Captured with the Phoenix ICON (100° field of view). Image size 1240x1240. Wide-field fundus photograph of an infant.
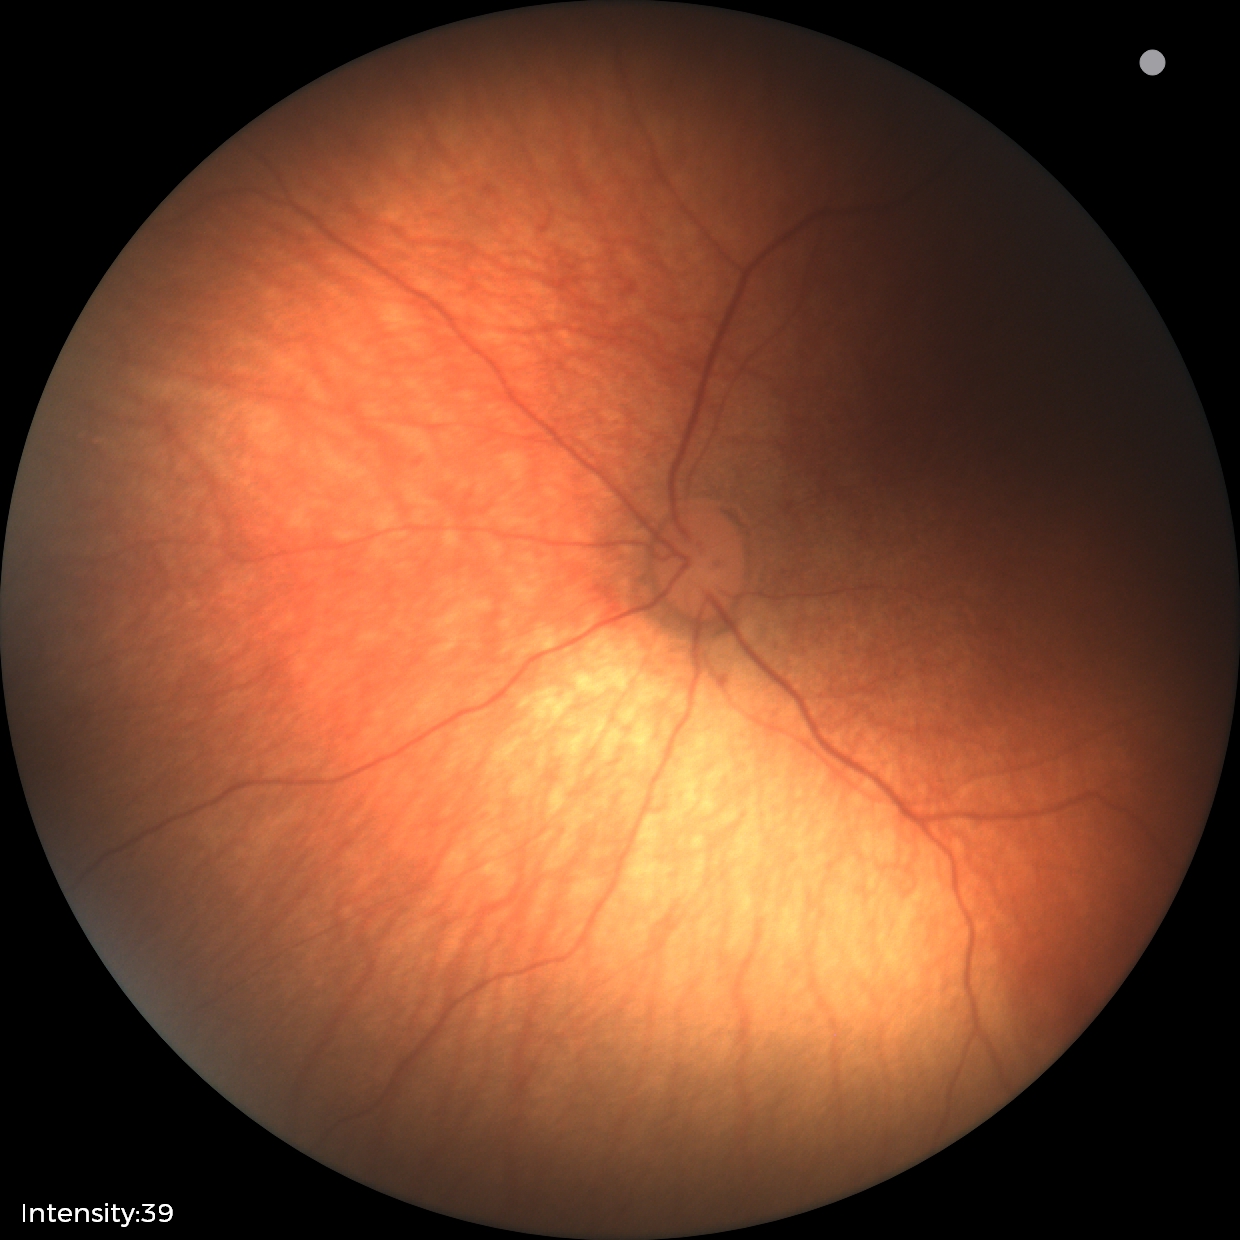
Q: What is the screening diagnosis?
A: normal retinal appearance